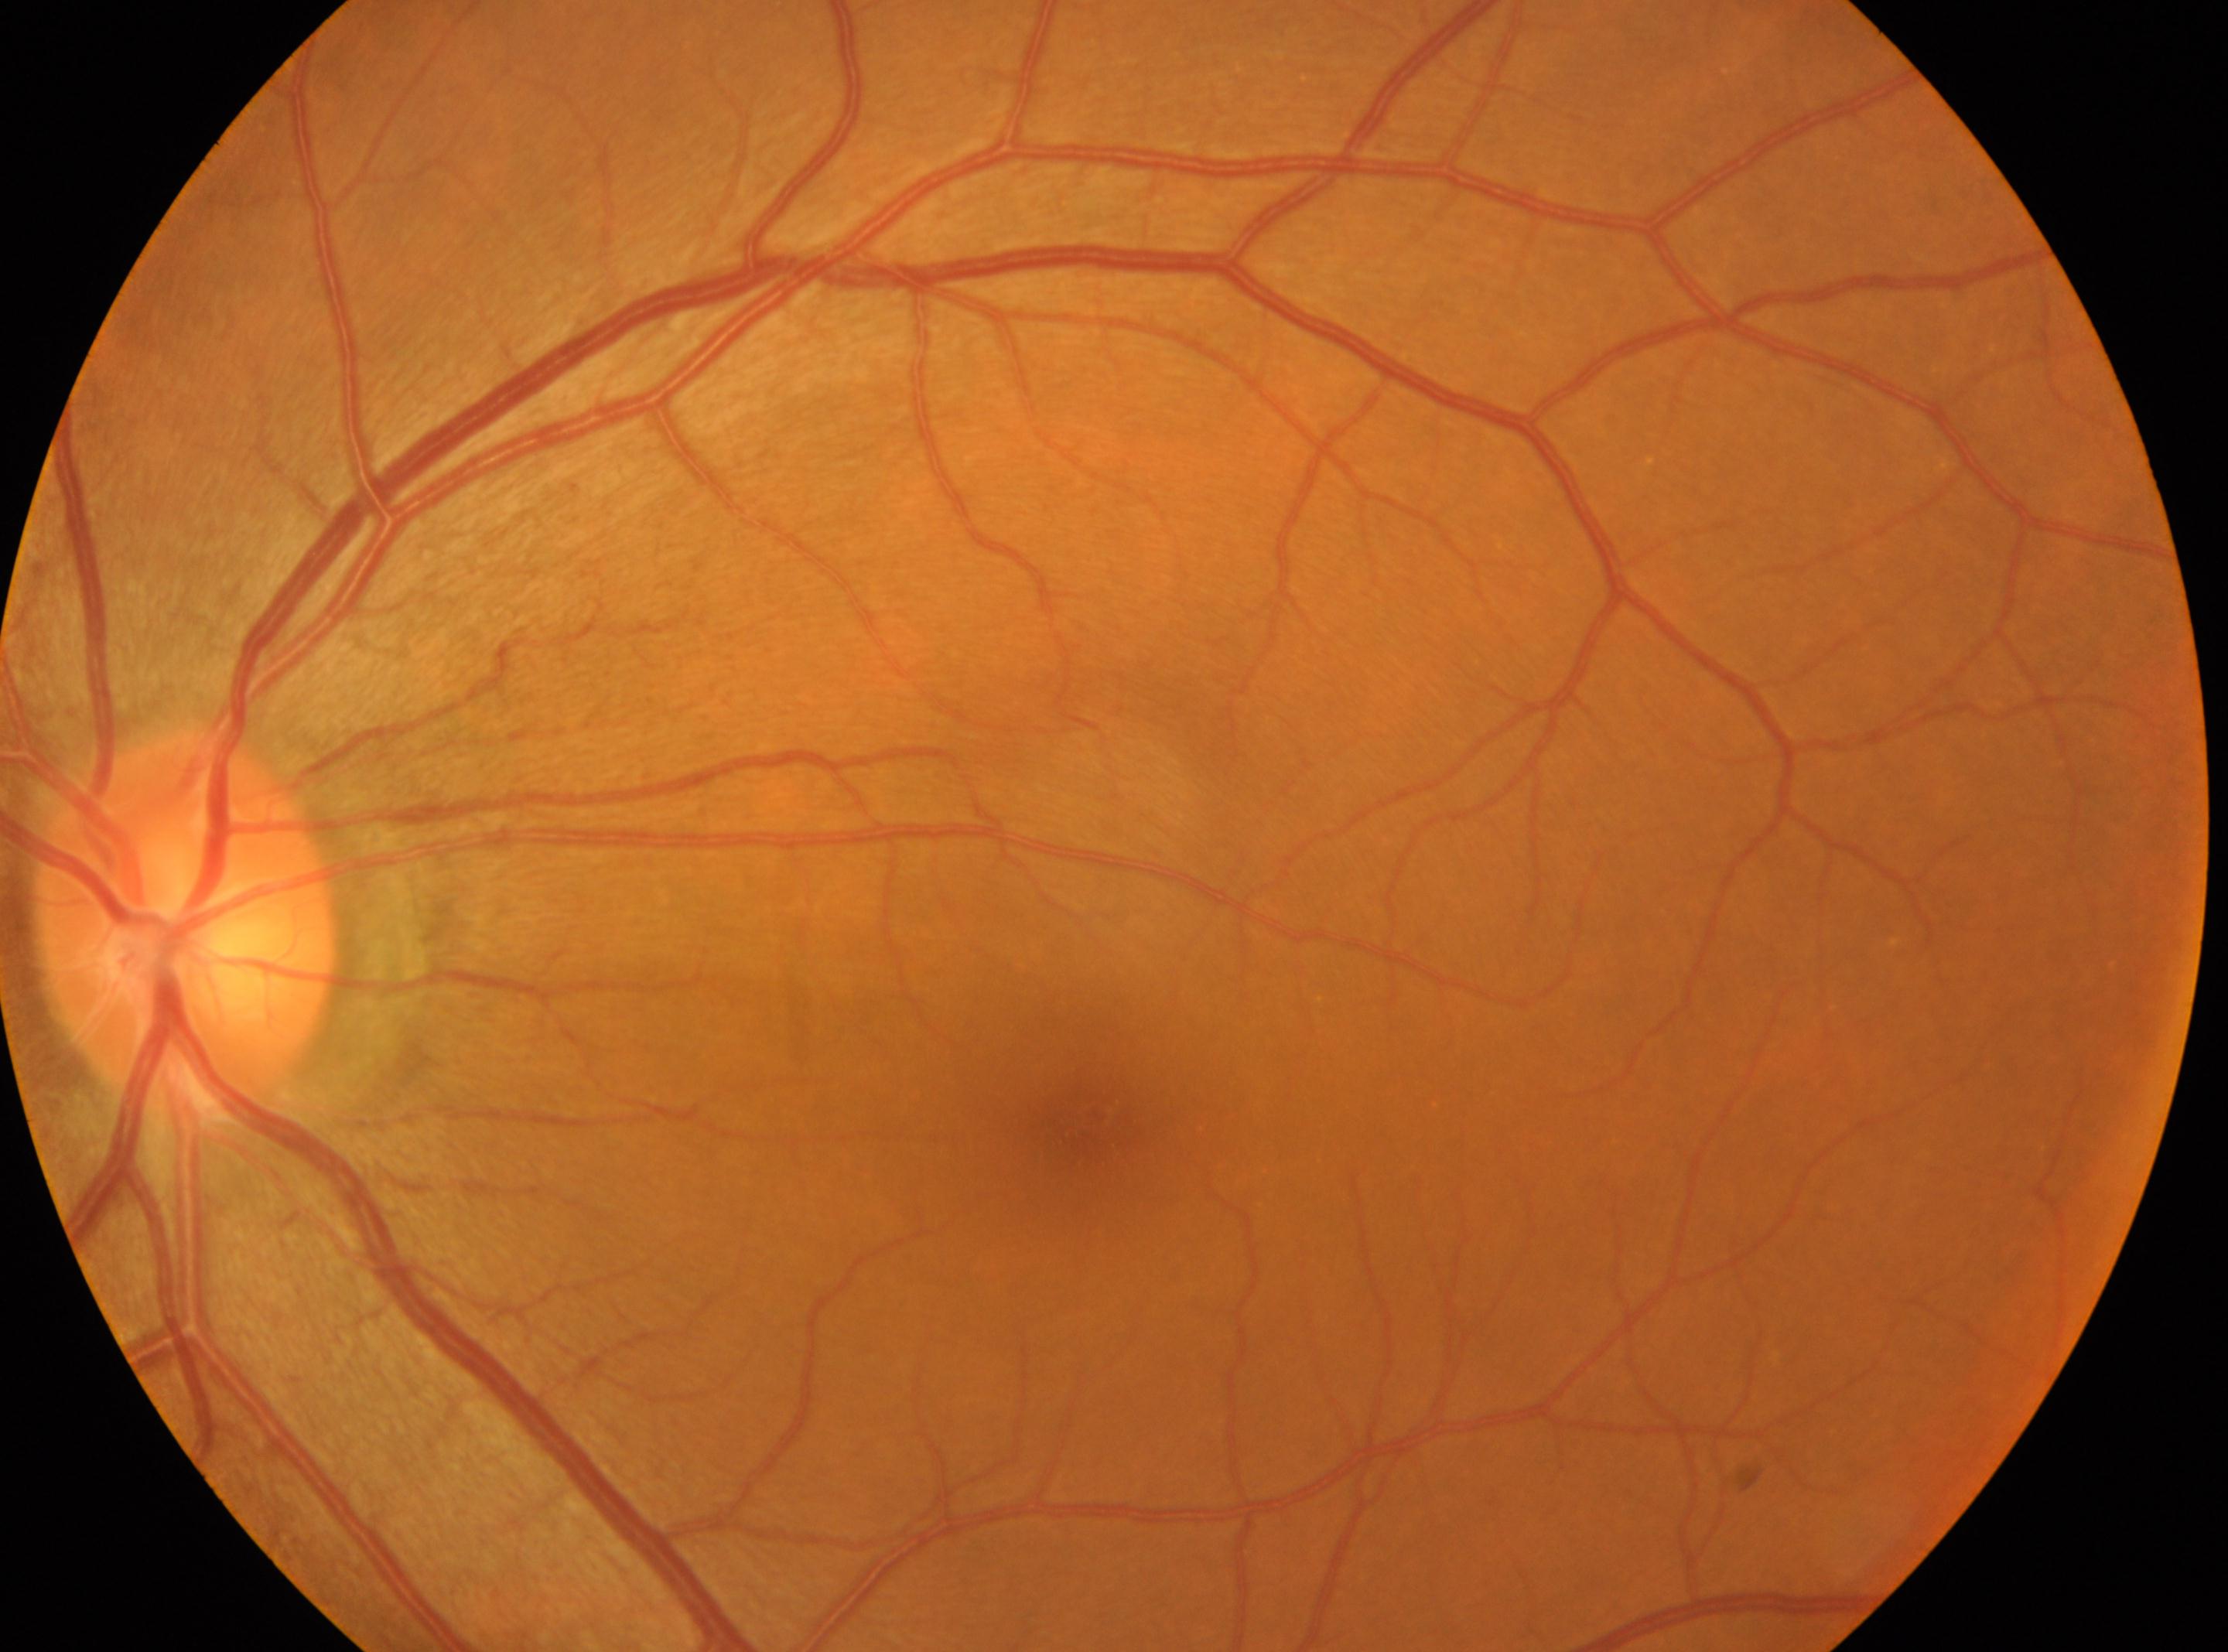 Macular center located at (1091, 1120).
This is the oculus sinister.
Diabetic retinopathy severity is 0/4.
Optic disk: (184, 923).